Modified Davis grading:
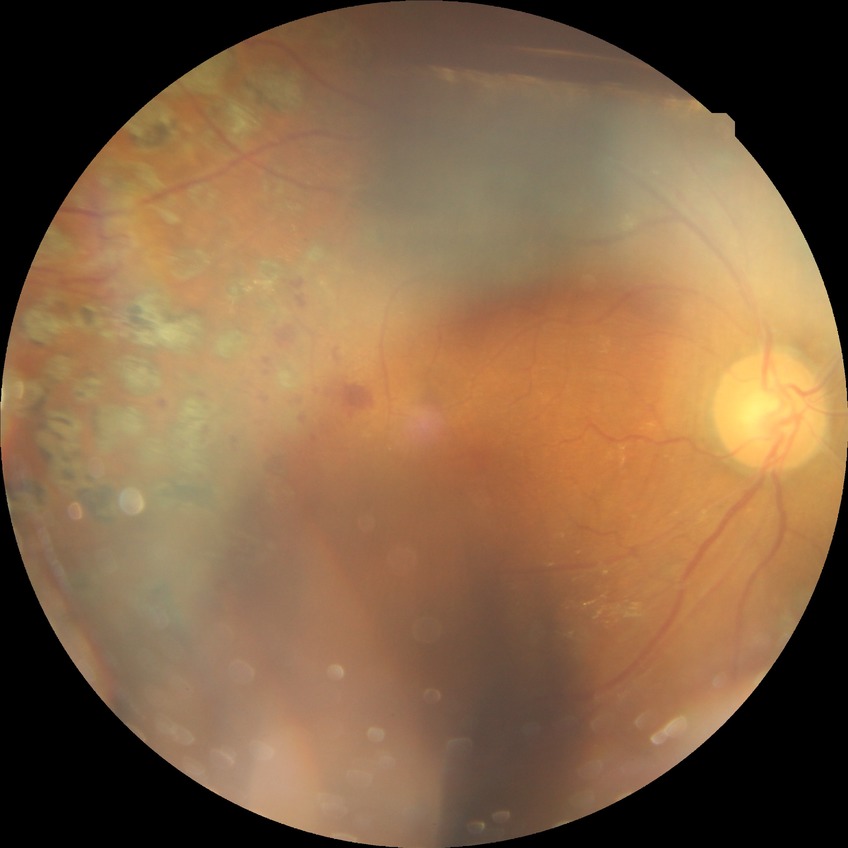
  davis_grade: PDR